No pharmacologic dilation.
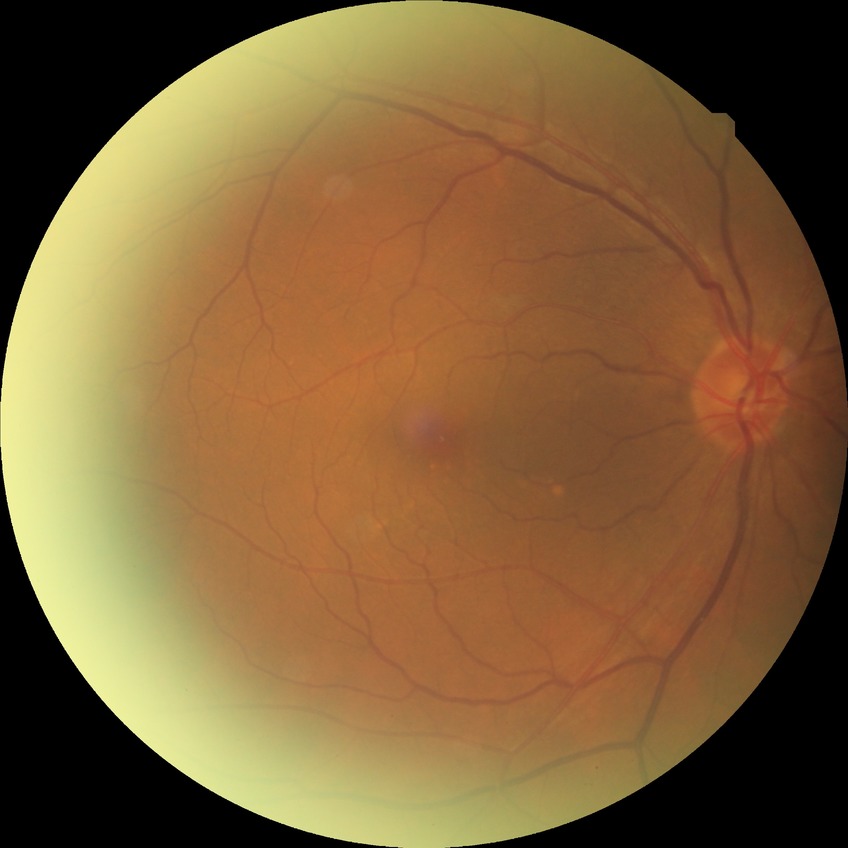
{
  "davis_grade": "no diabetic retinopathy (NDR)"
}